45° field of view · Davis DR grading · image size 848x848 — 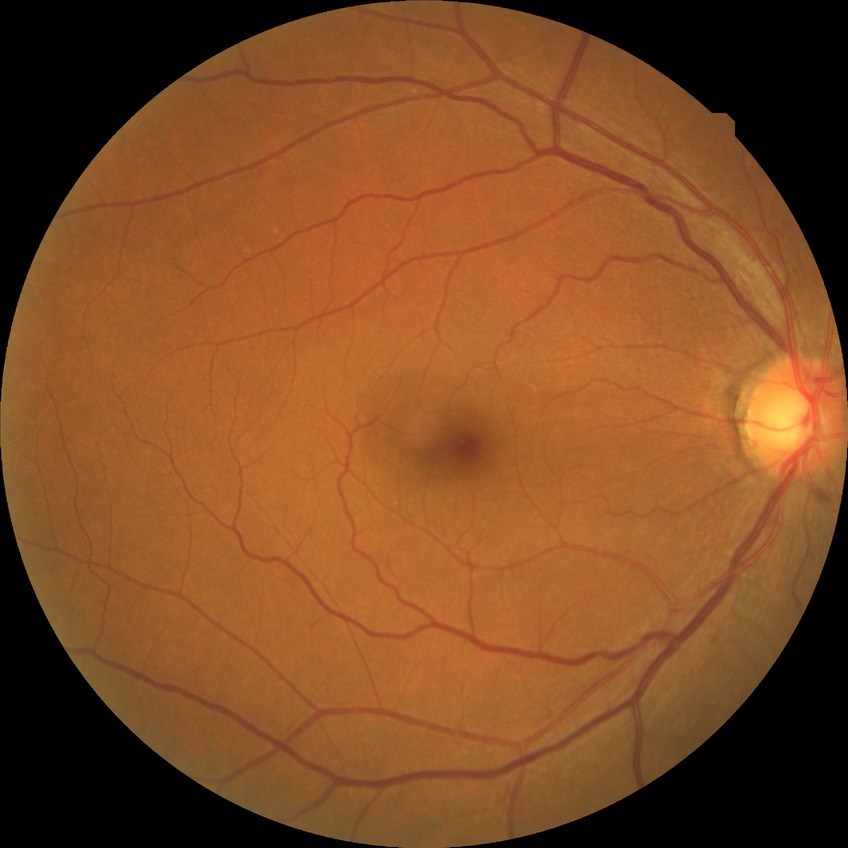
{"davis_grade": "NDR (no diabetic retinopathy)"}